Davis DR grading
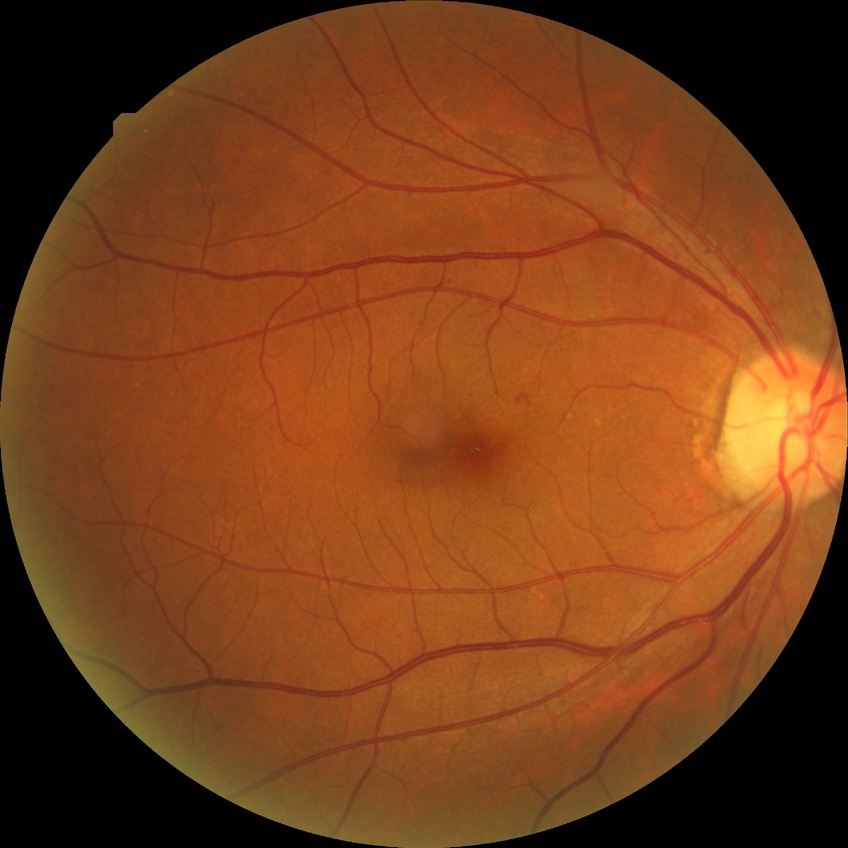
DR grade is NDR.